DR severity per modified Davis staging · 848 x 848 pixels · NIDEK AFC-230 — 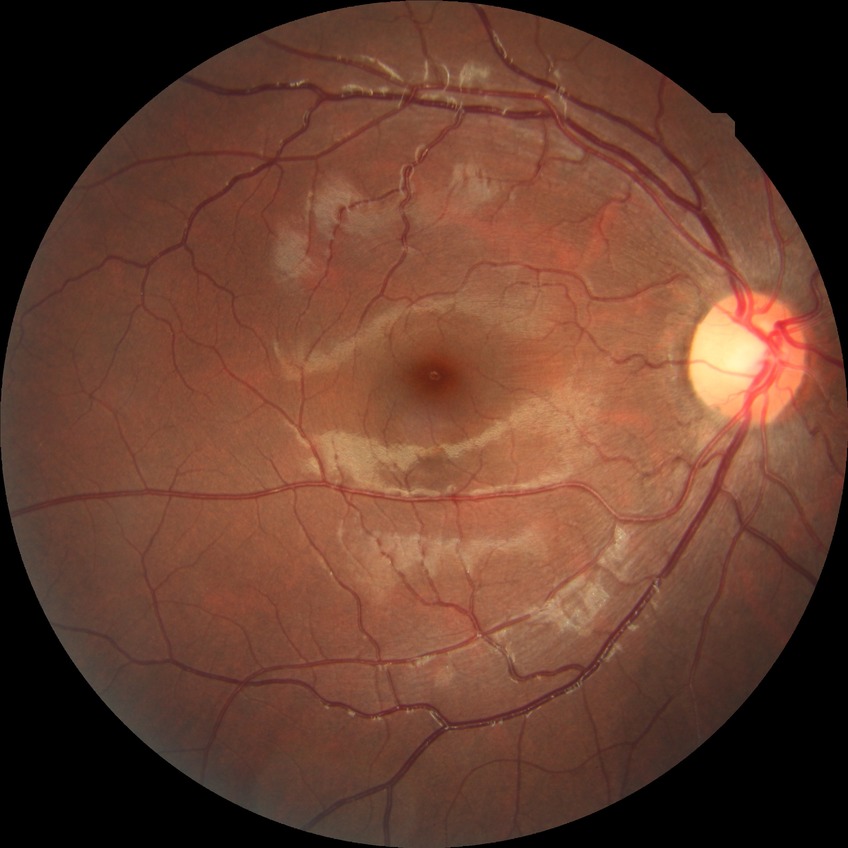
Diabetic retinopathy (DR) is no diabetic retinopathy (NDR).